Image size 1440x1080 · pediatric wide-field fundus photograph:
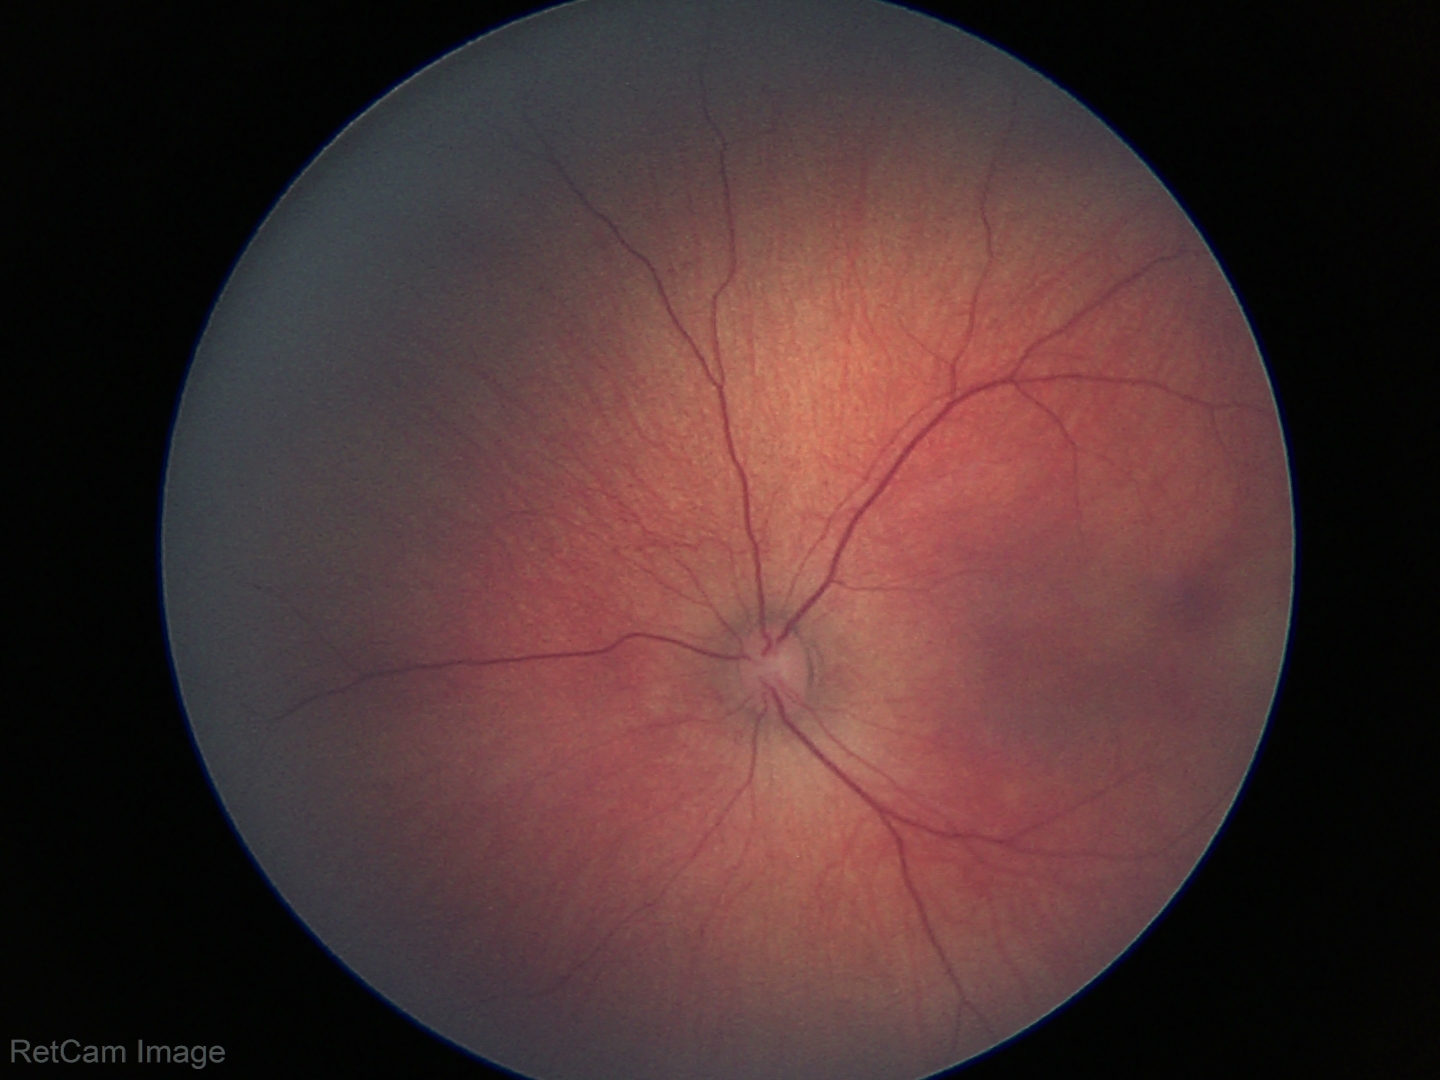

Diagnosis = normal.